240 by 240 pixels · color fundus photograph.
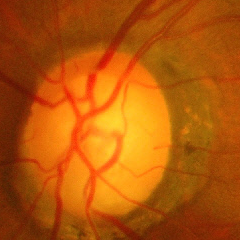 Impression: advanced glaucoma.